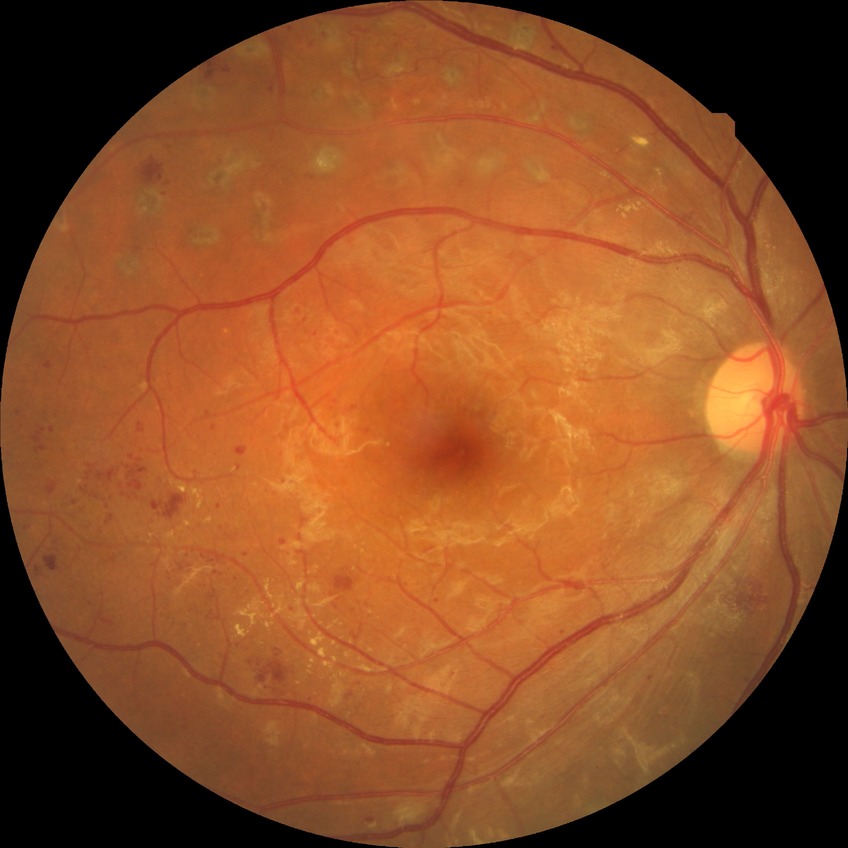
Diabetic retinopathy grade: proliferative diabetic retinopathy.